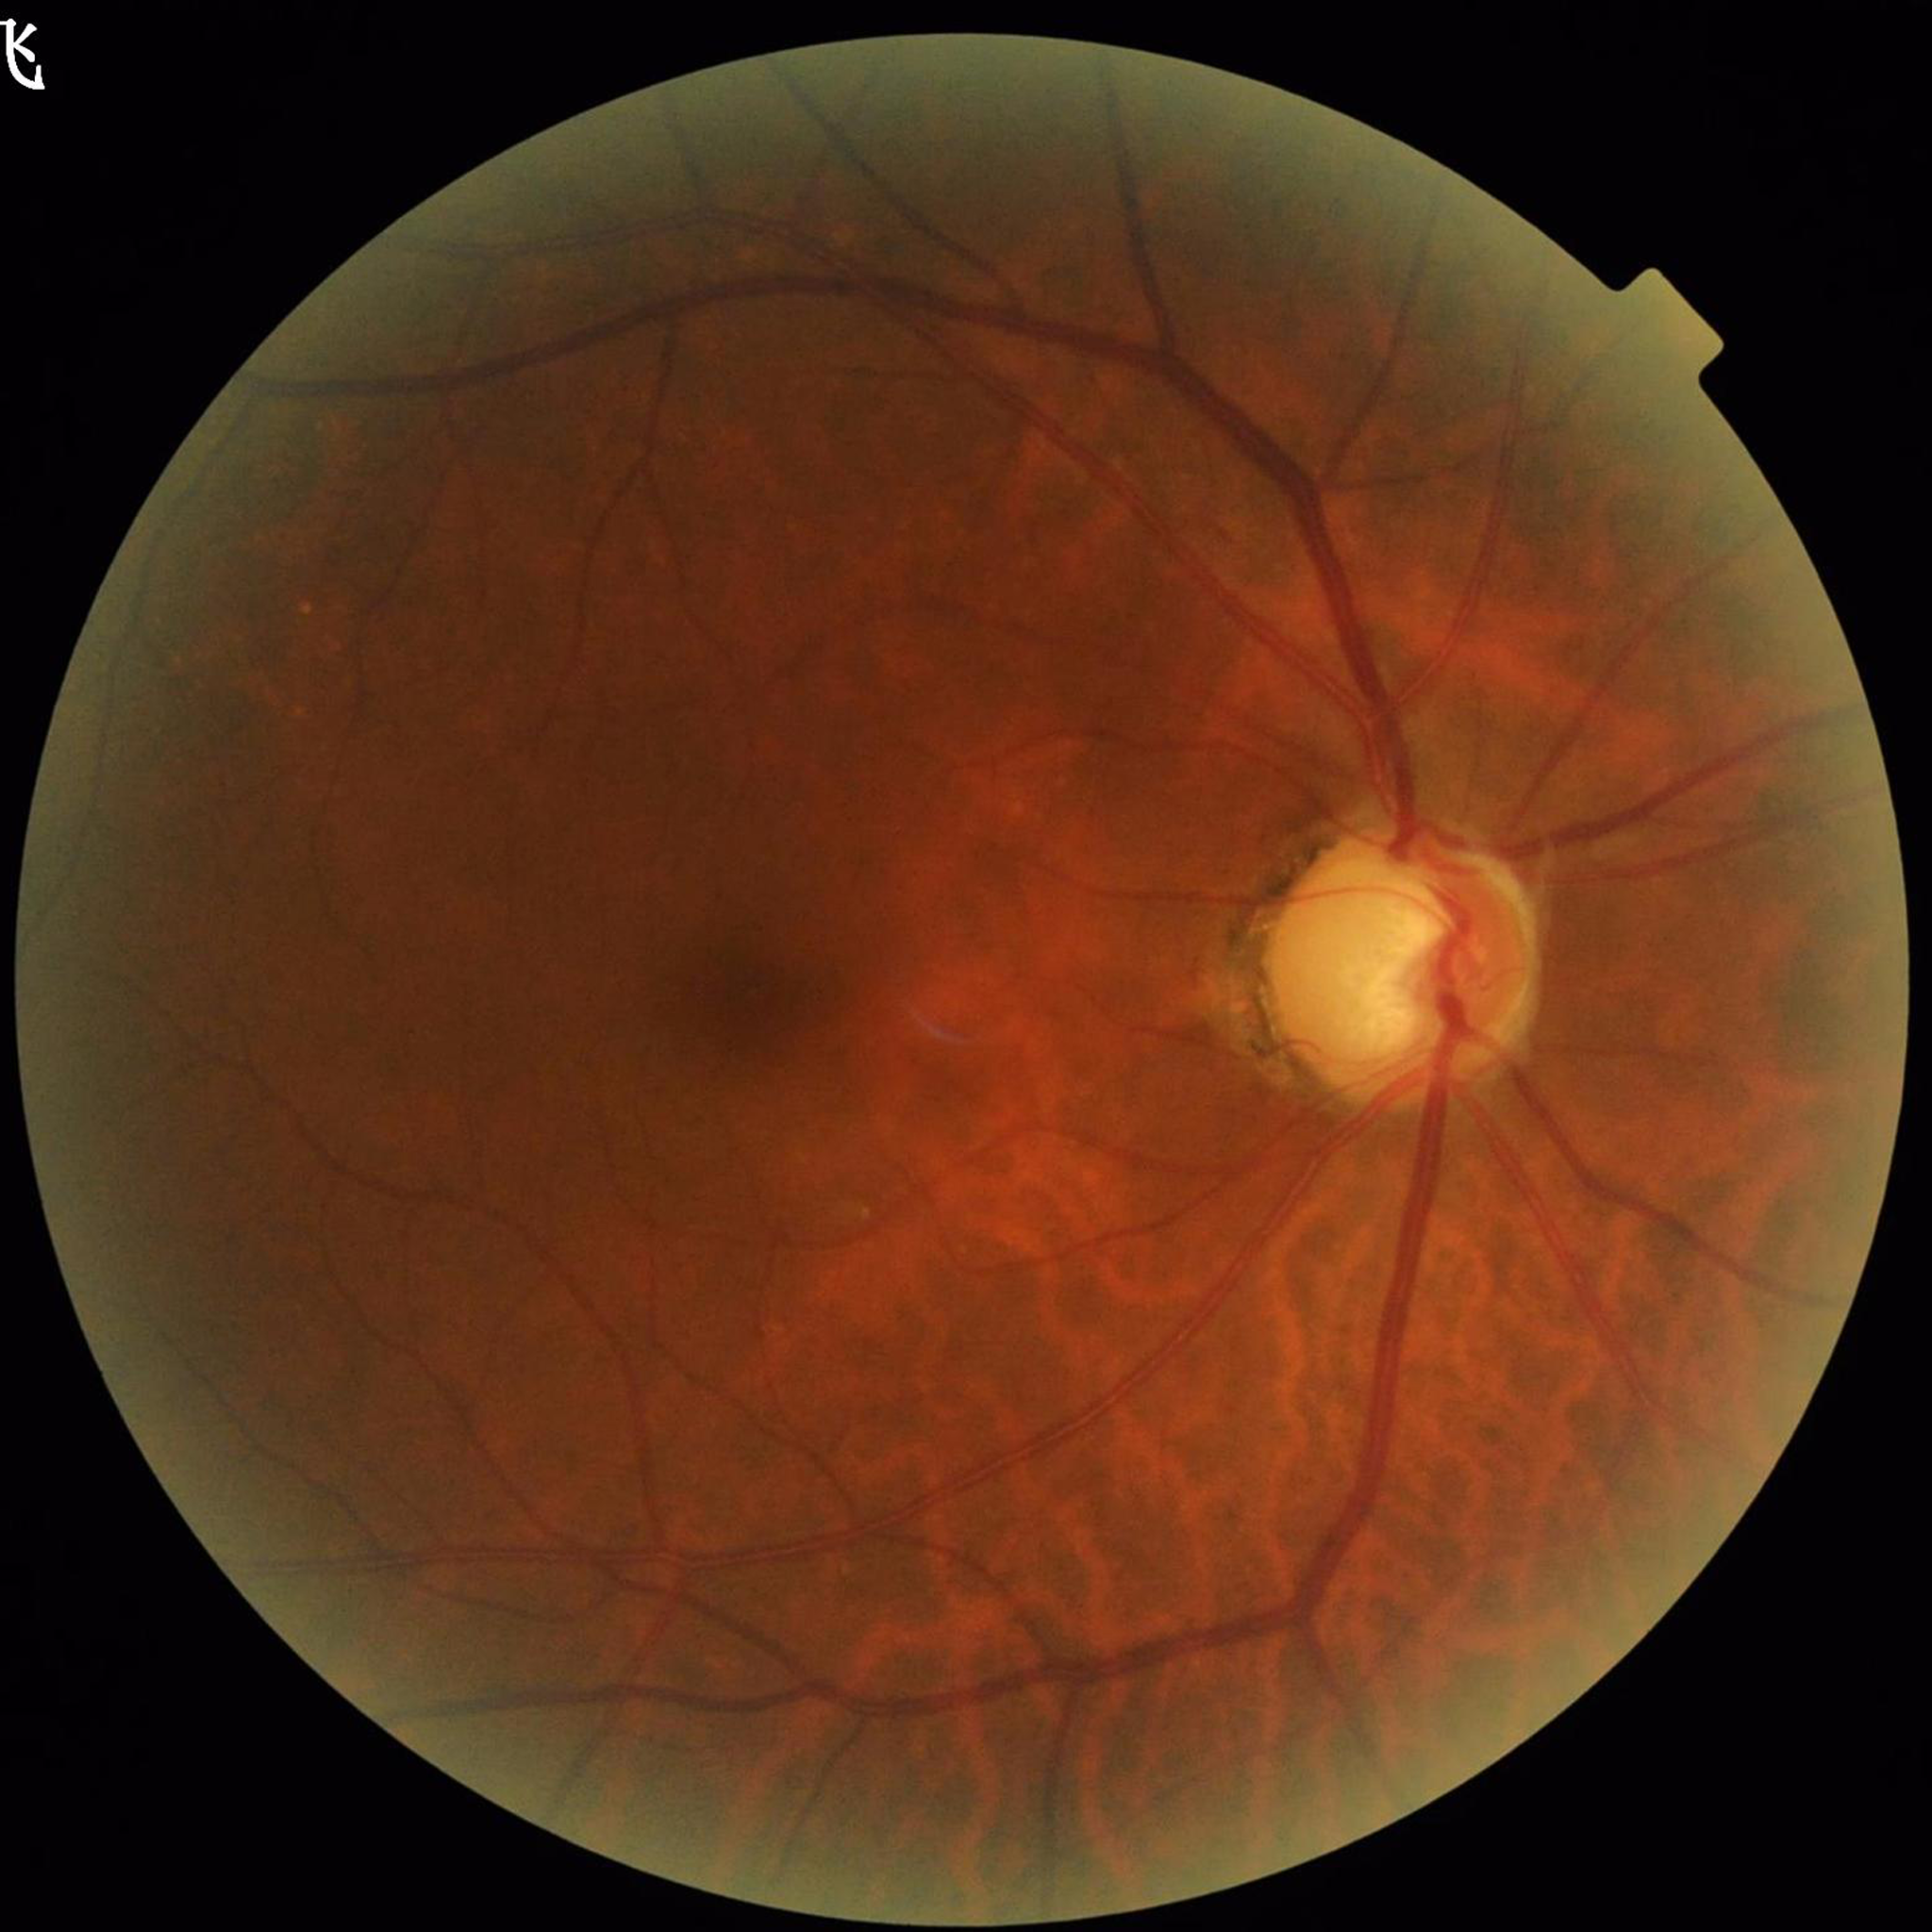

Patient diagnosed with glaucoma.